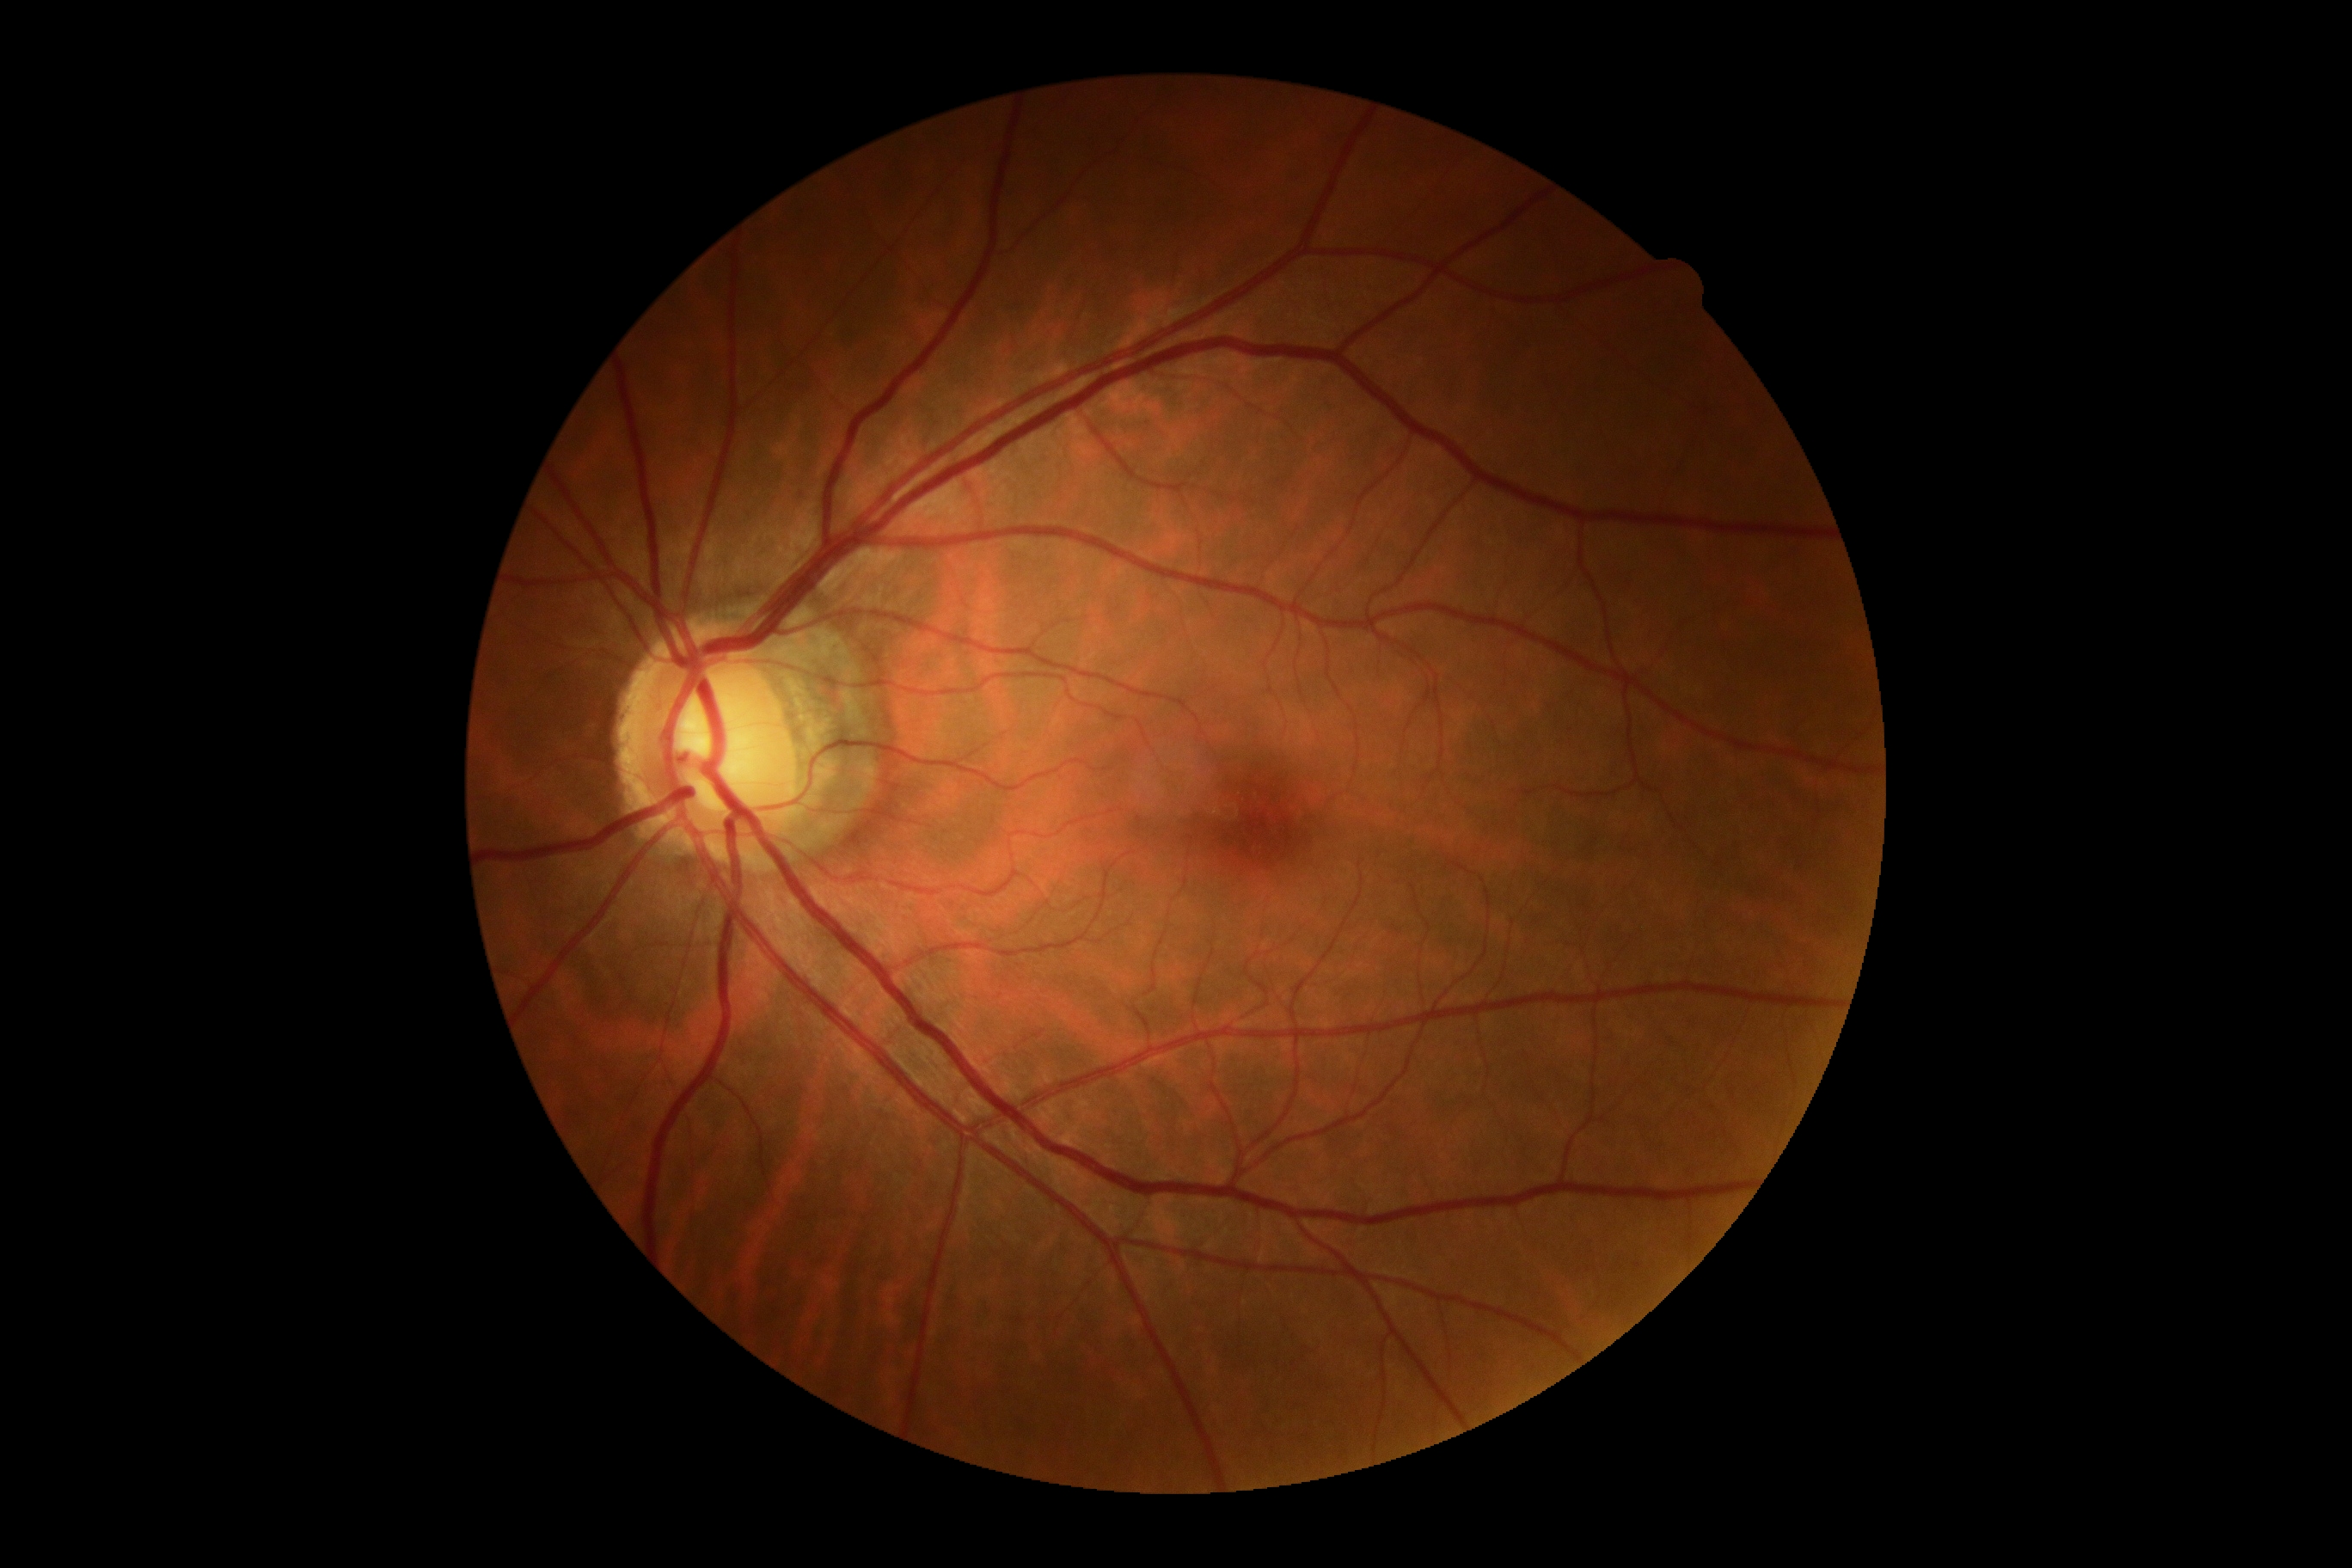 DR: grade 0.